Pediatric wide-field fundus photograph. Clarity RetCam 3, 130° FOV.
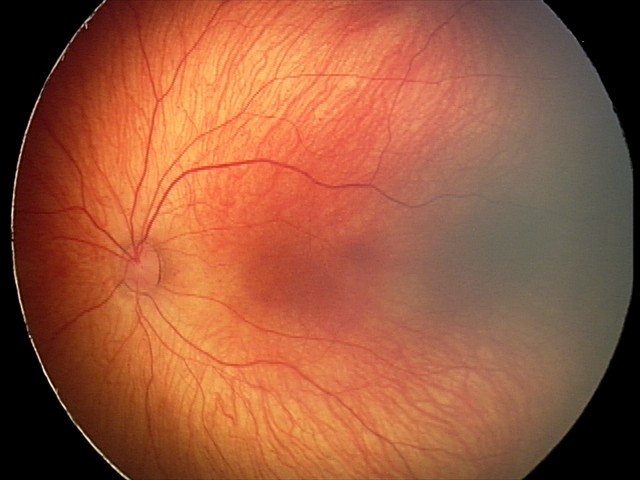 Diagnosis from this screening exam: retinal hemorrhages.